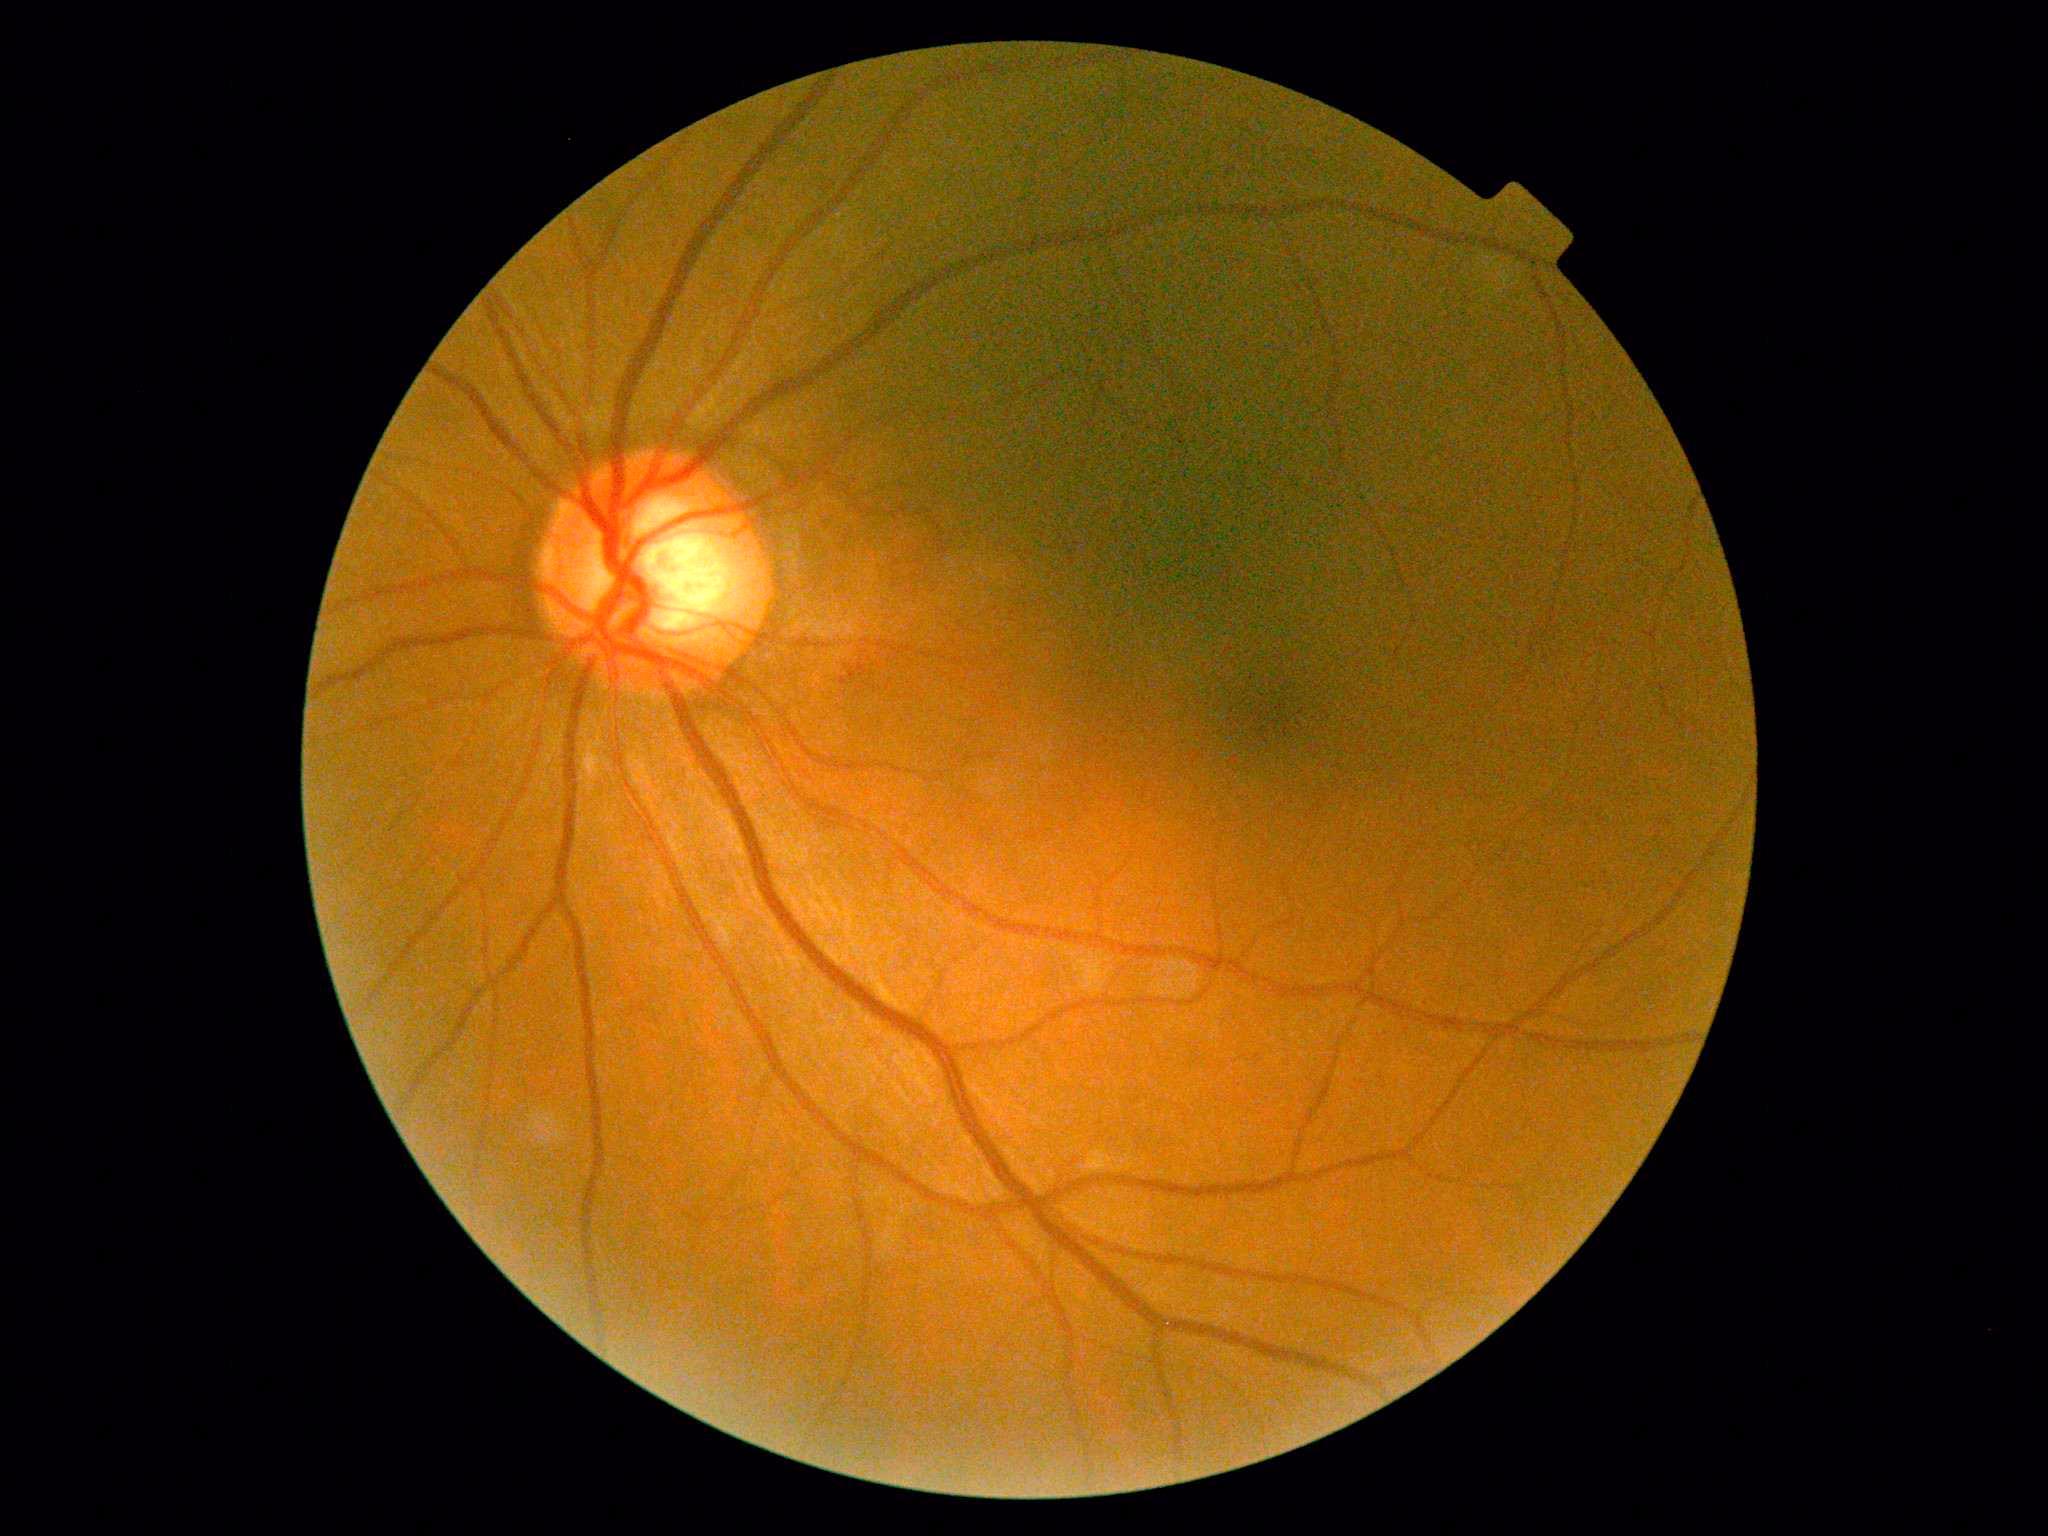

Findings:
• diabetic retinopathy severity: 0/4